Pediatric wide-field fundus photograph; 1440x1080
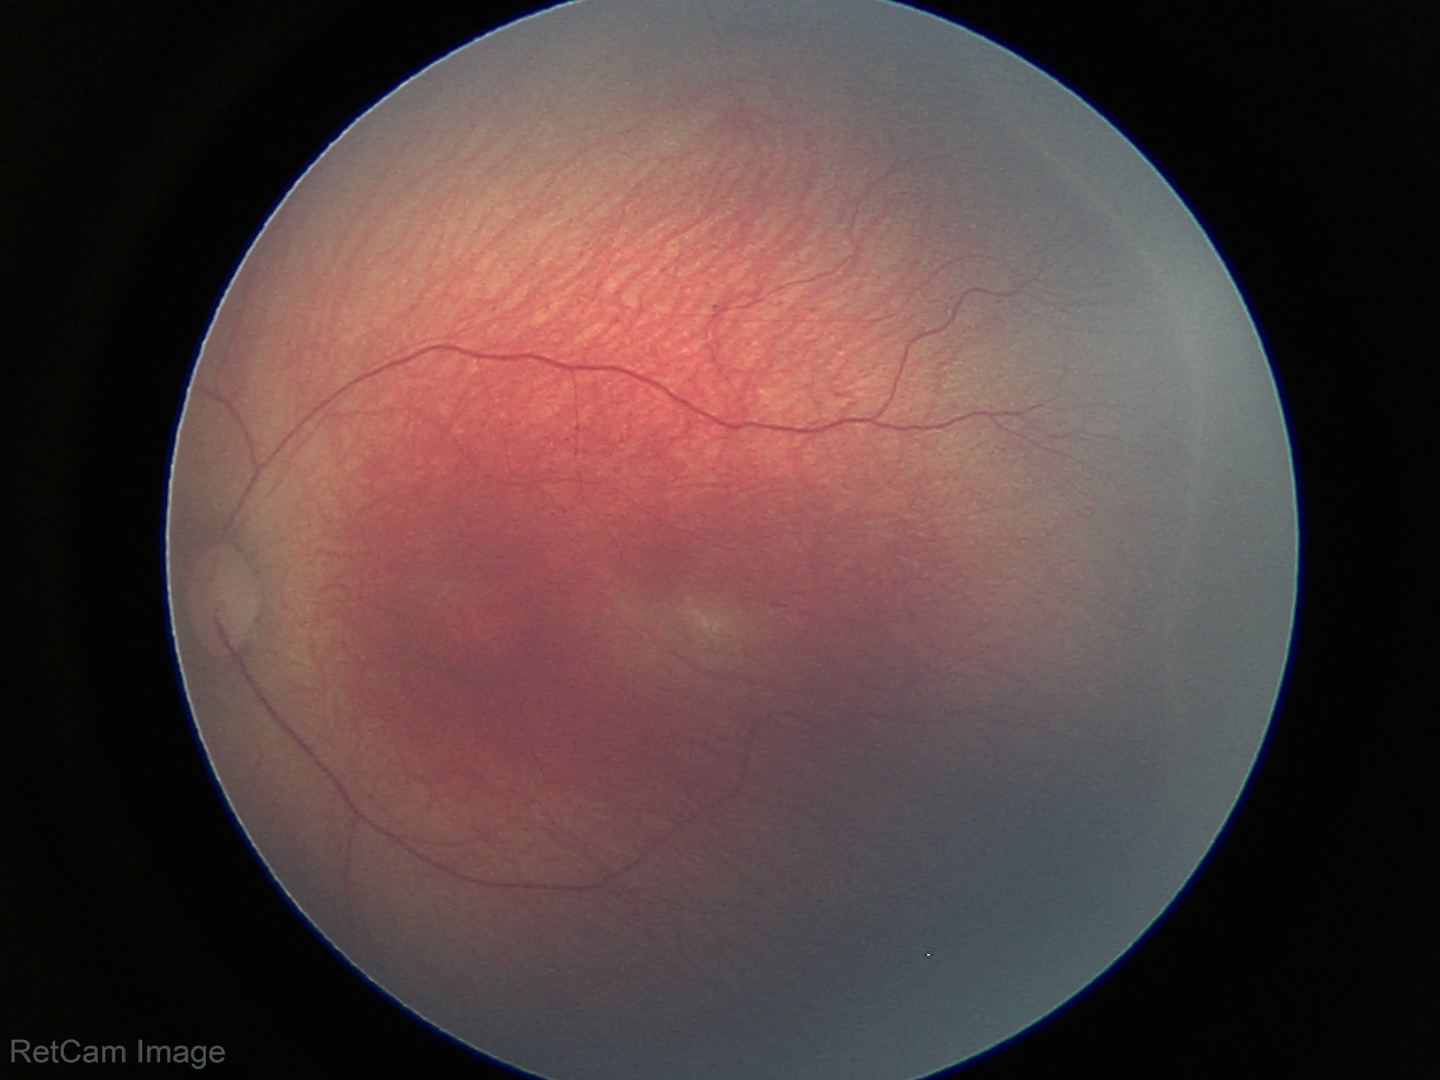

Plus disease: absent — posterior pole vessels without abnormal dilation or tortuosity, assessment: retinopathy of prematurity stage 2.